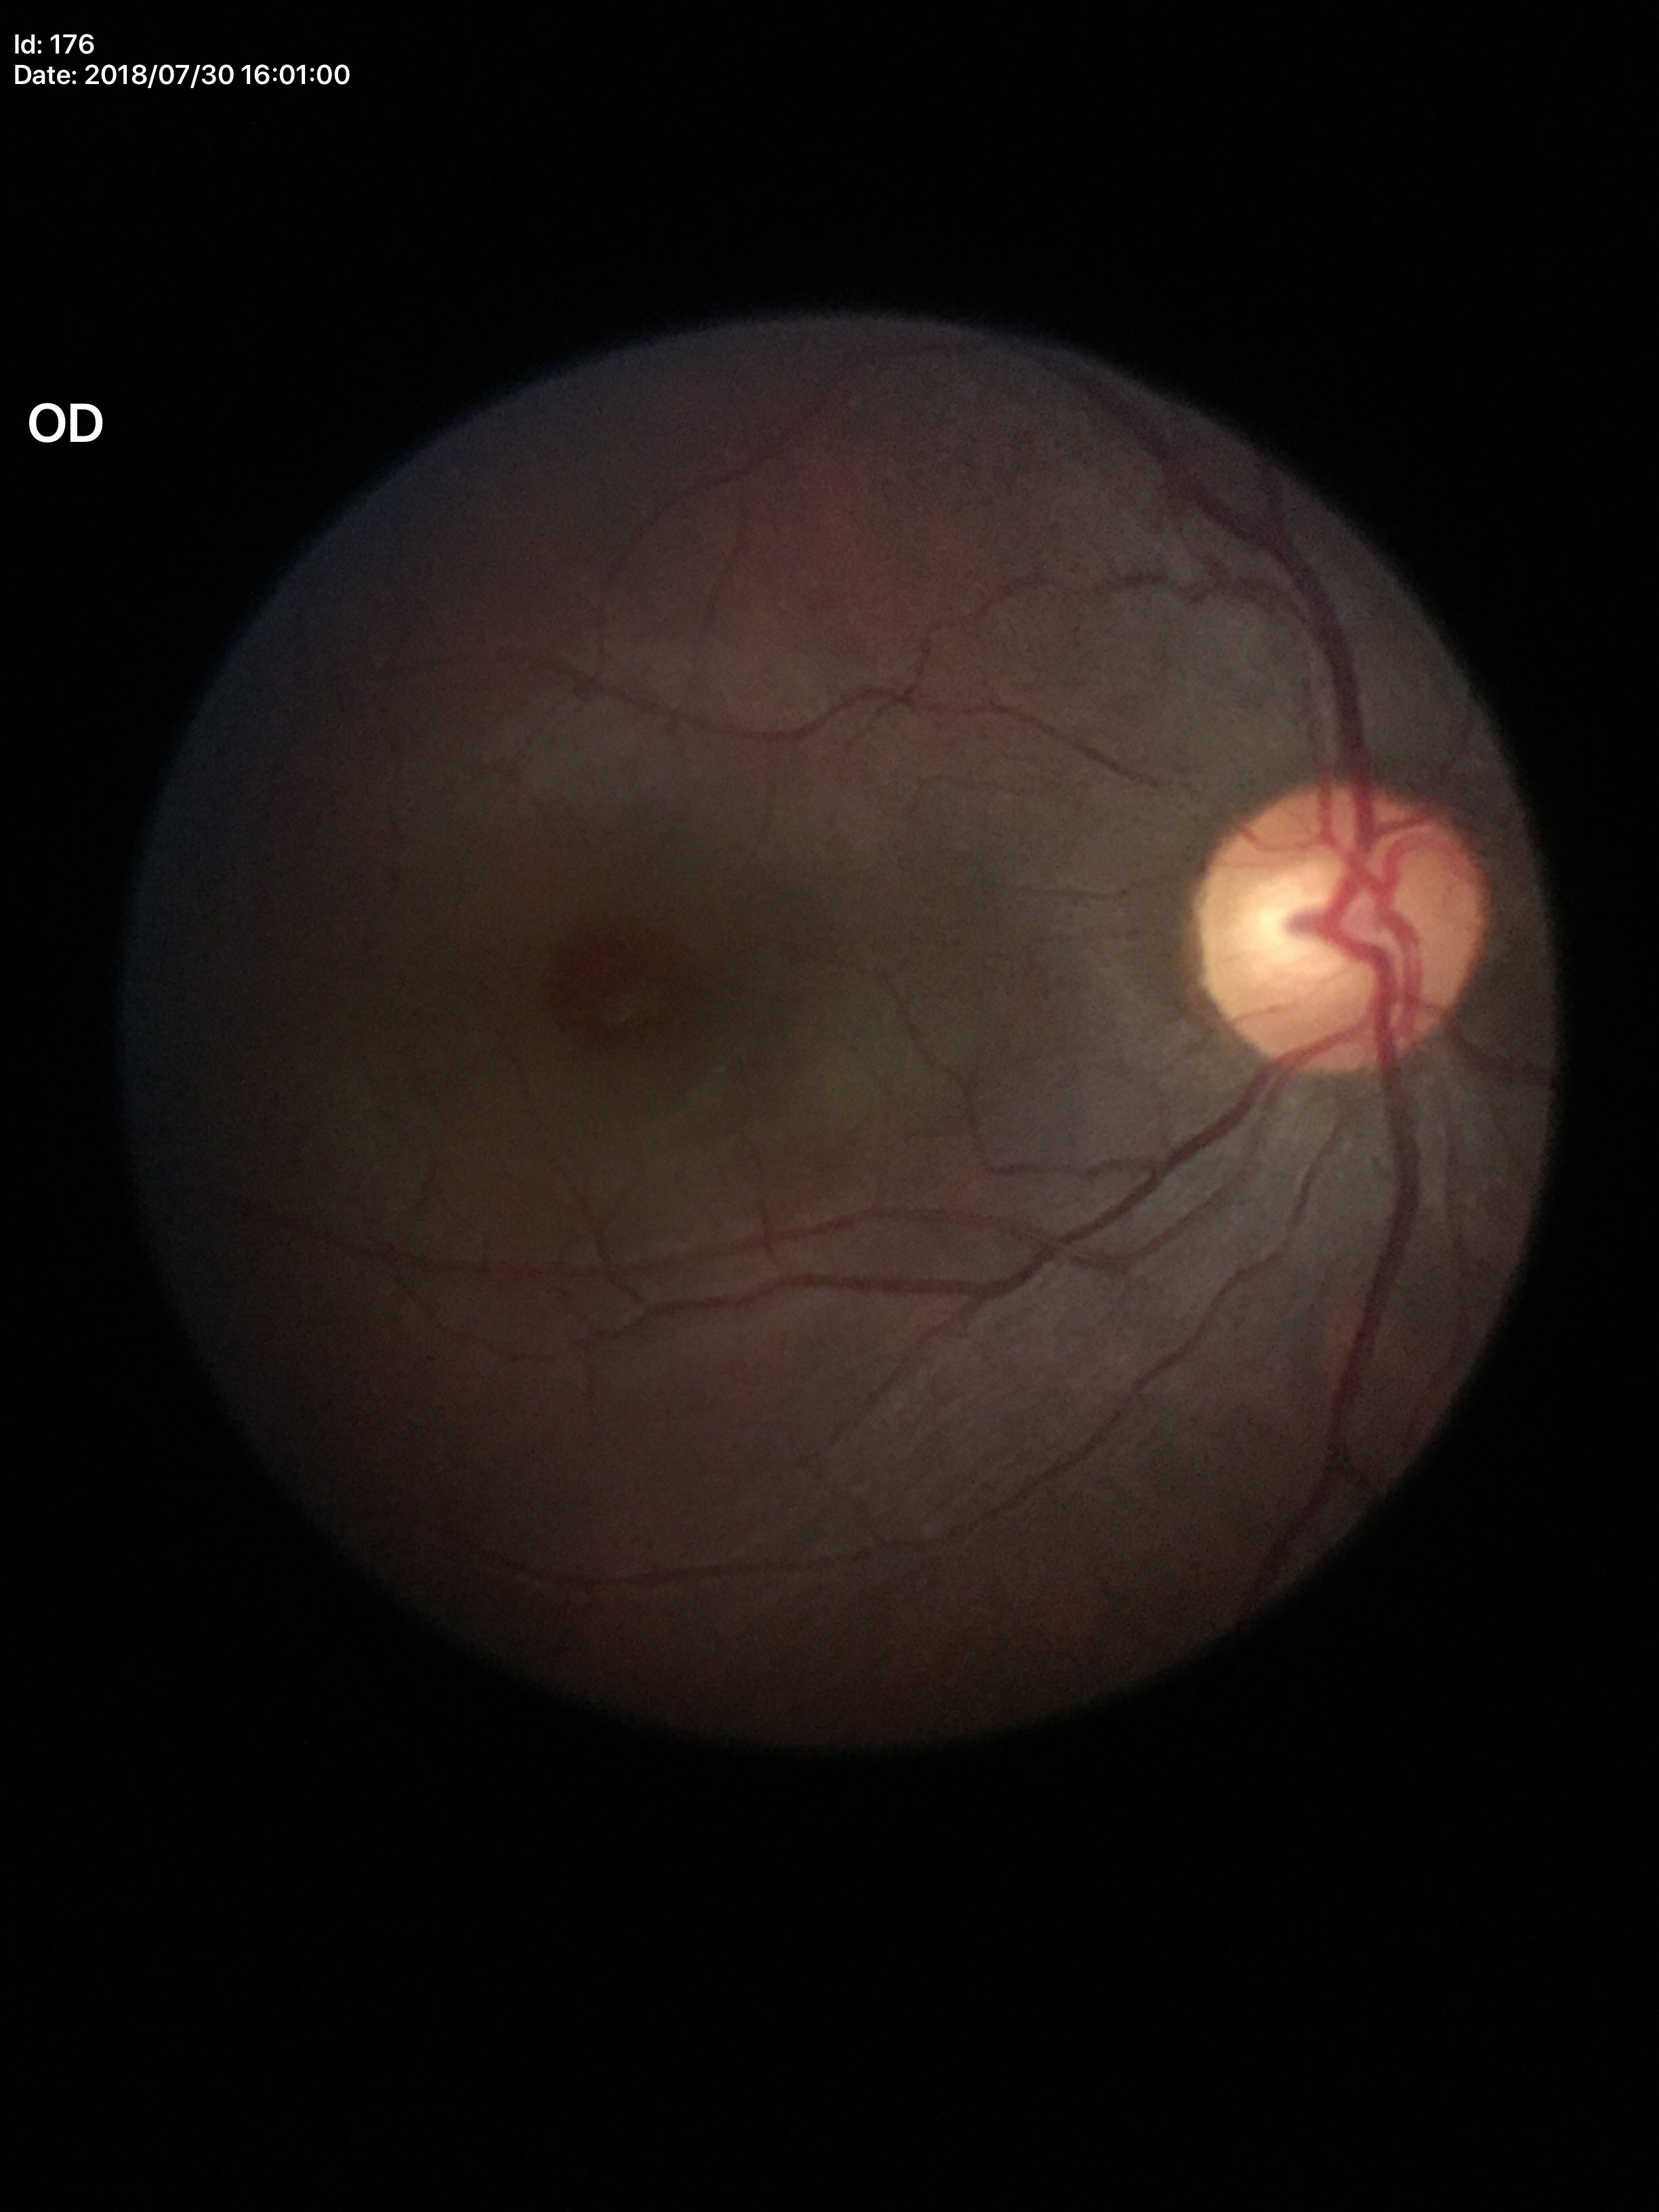

Glaucoma evaluation = no suspicious findings; vertical C/D ratio (VCDR) = 0.53; horizontal C/D ratio (HCDR) = 0.57.